45 degree fundus photograph. NIDEK AFC-230 fundus camera. Image size 848x848 — 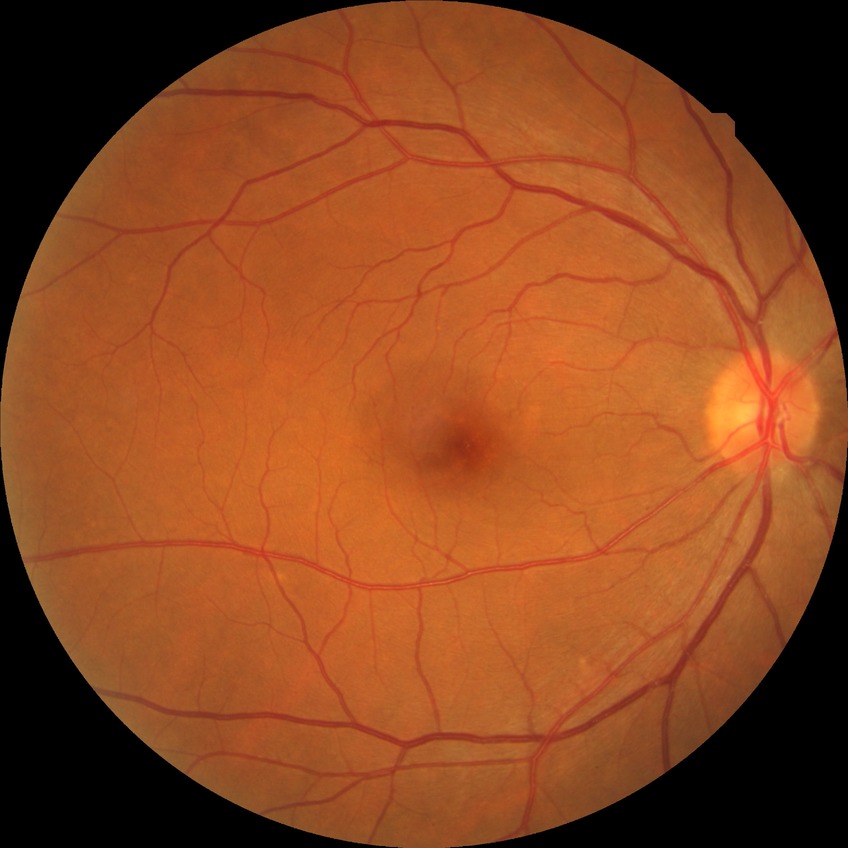
Retinopathy stage is no diabetic retinopathy.